Pediatric retinal photograph (wide-field).
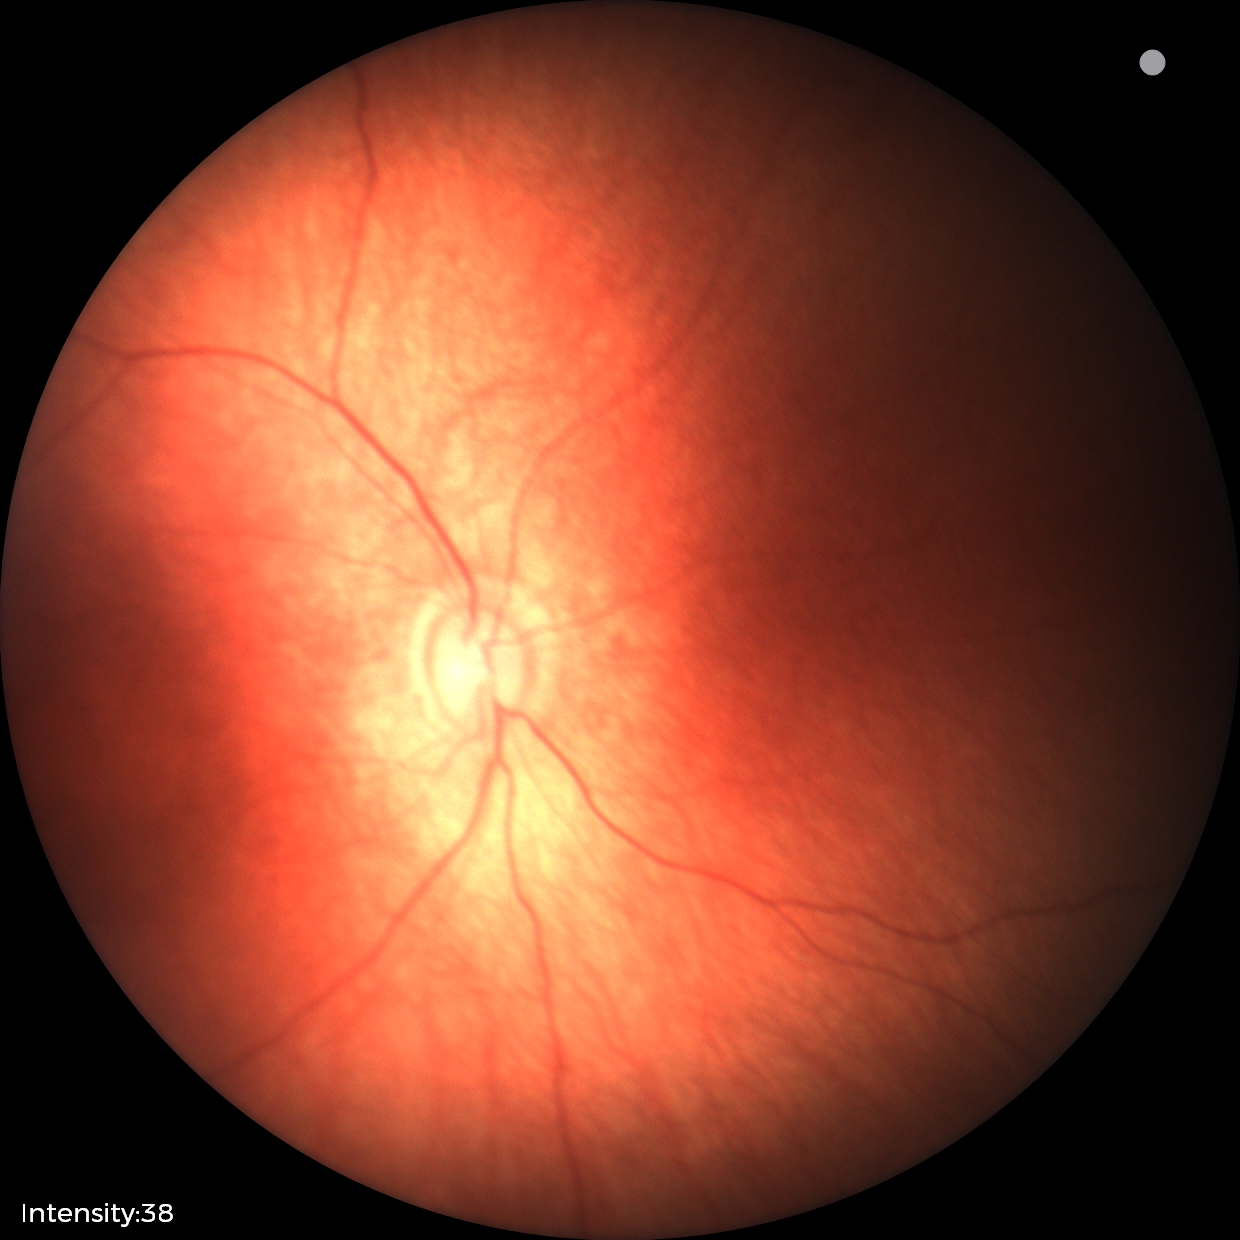
Normal screening examination.